2352x1568, 45-degree field of view — 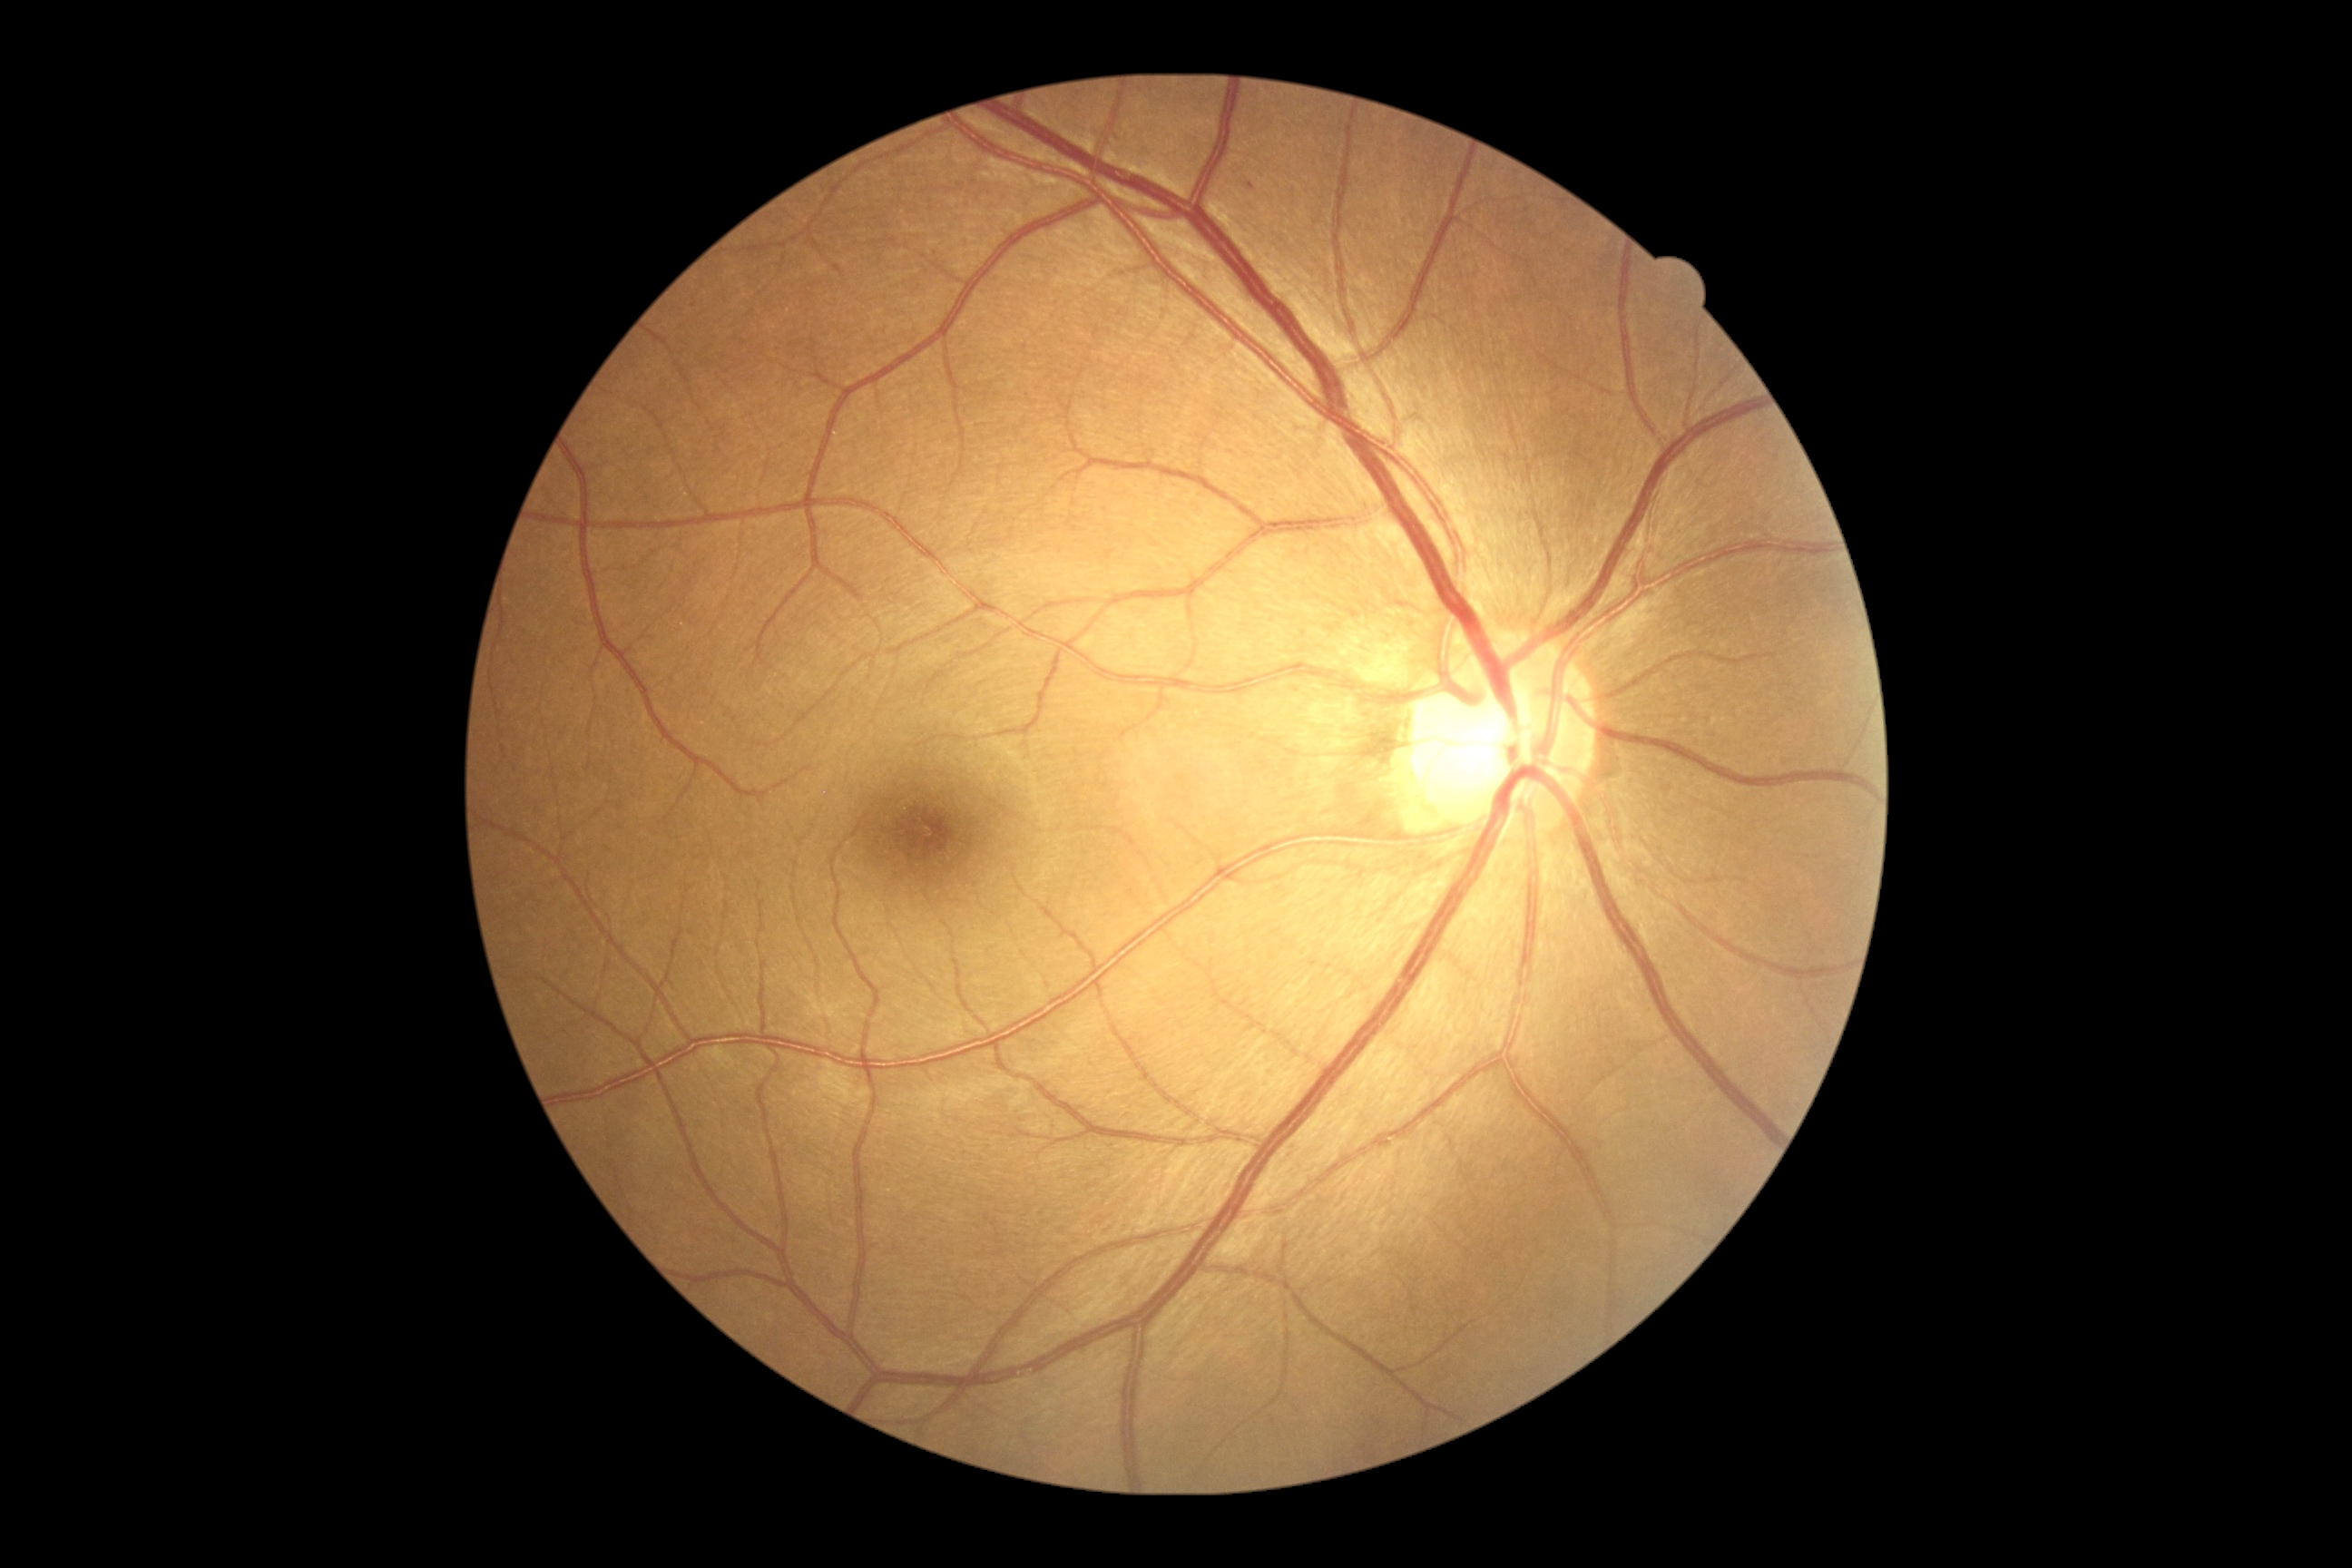 The retinopathy is classified as non-proliferative diabetic retinopathy.
DR stage is grade 1 (mild NPDR).